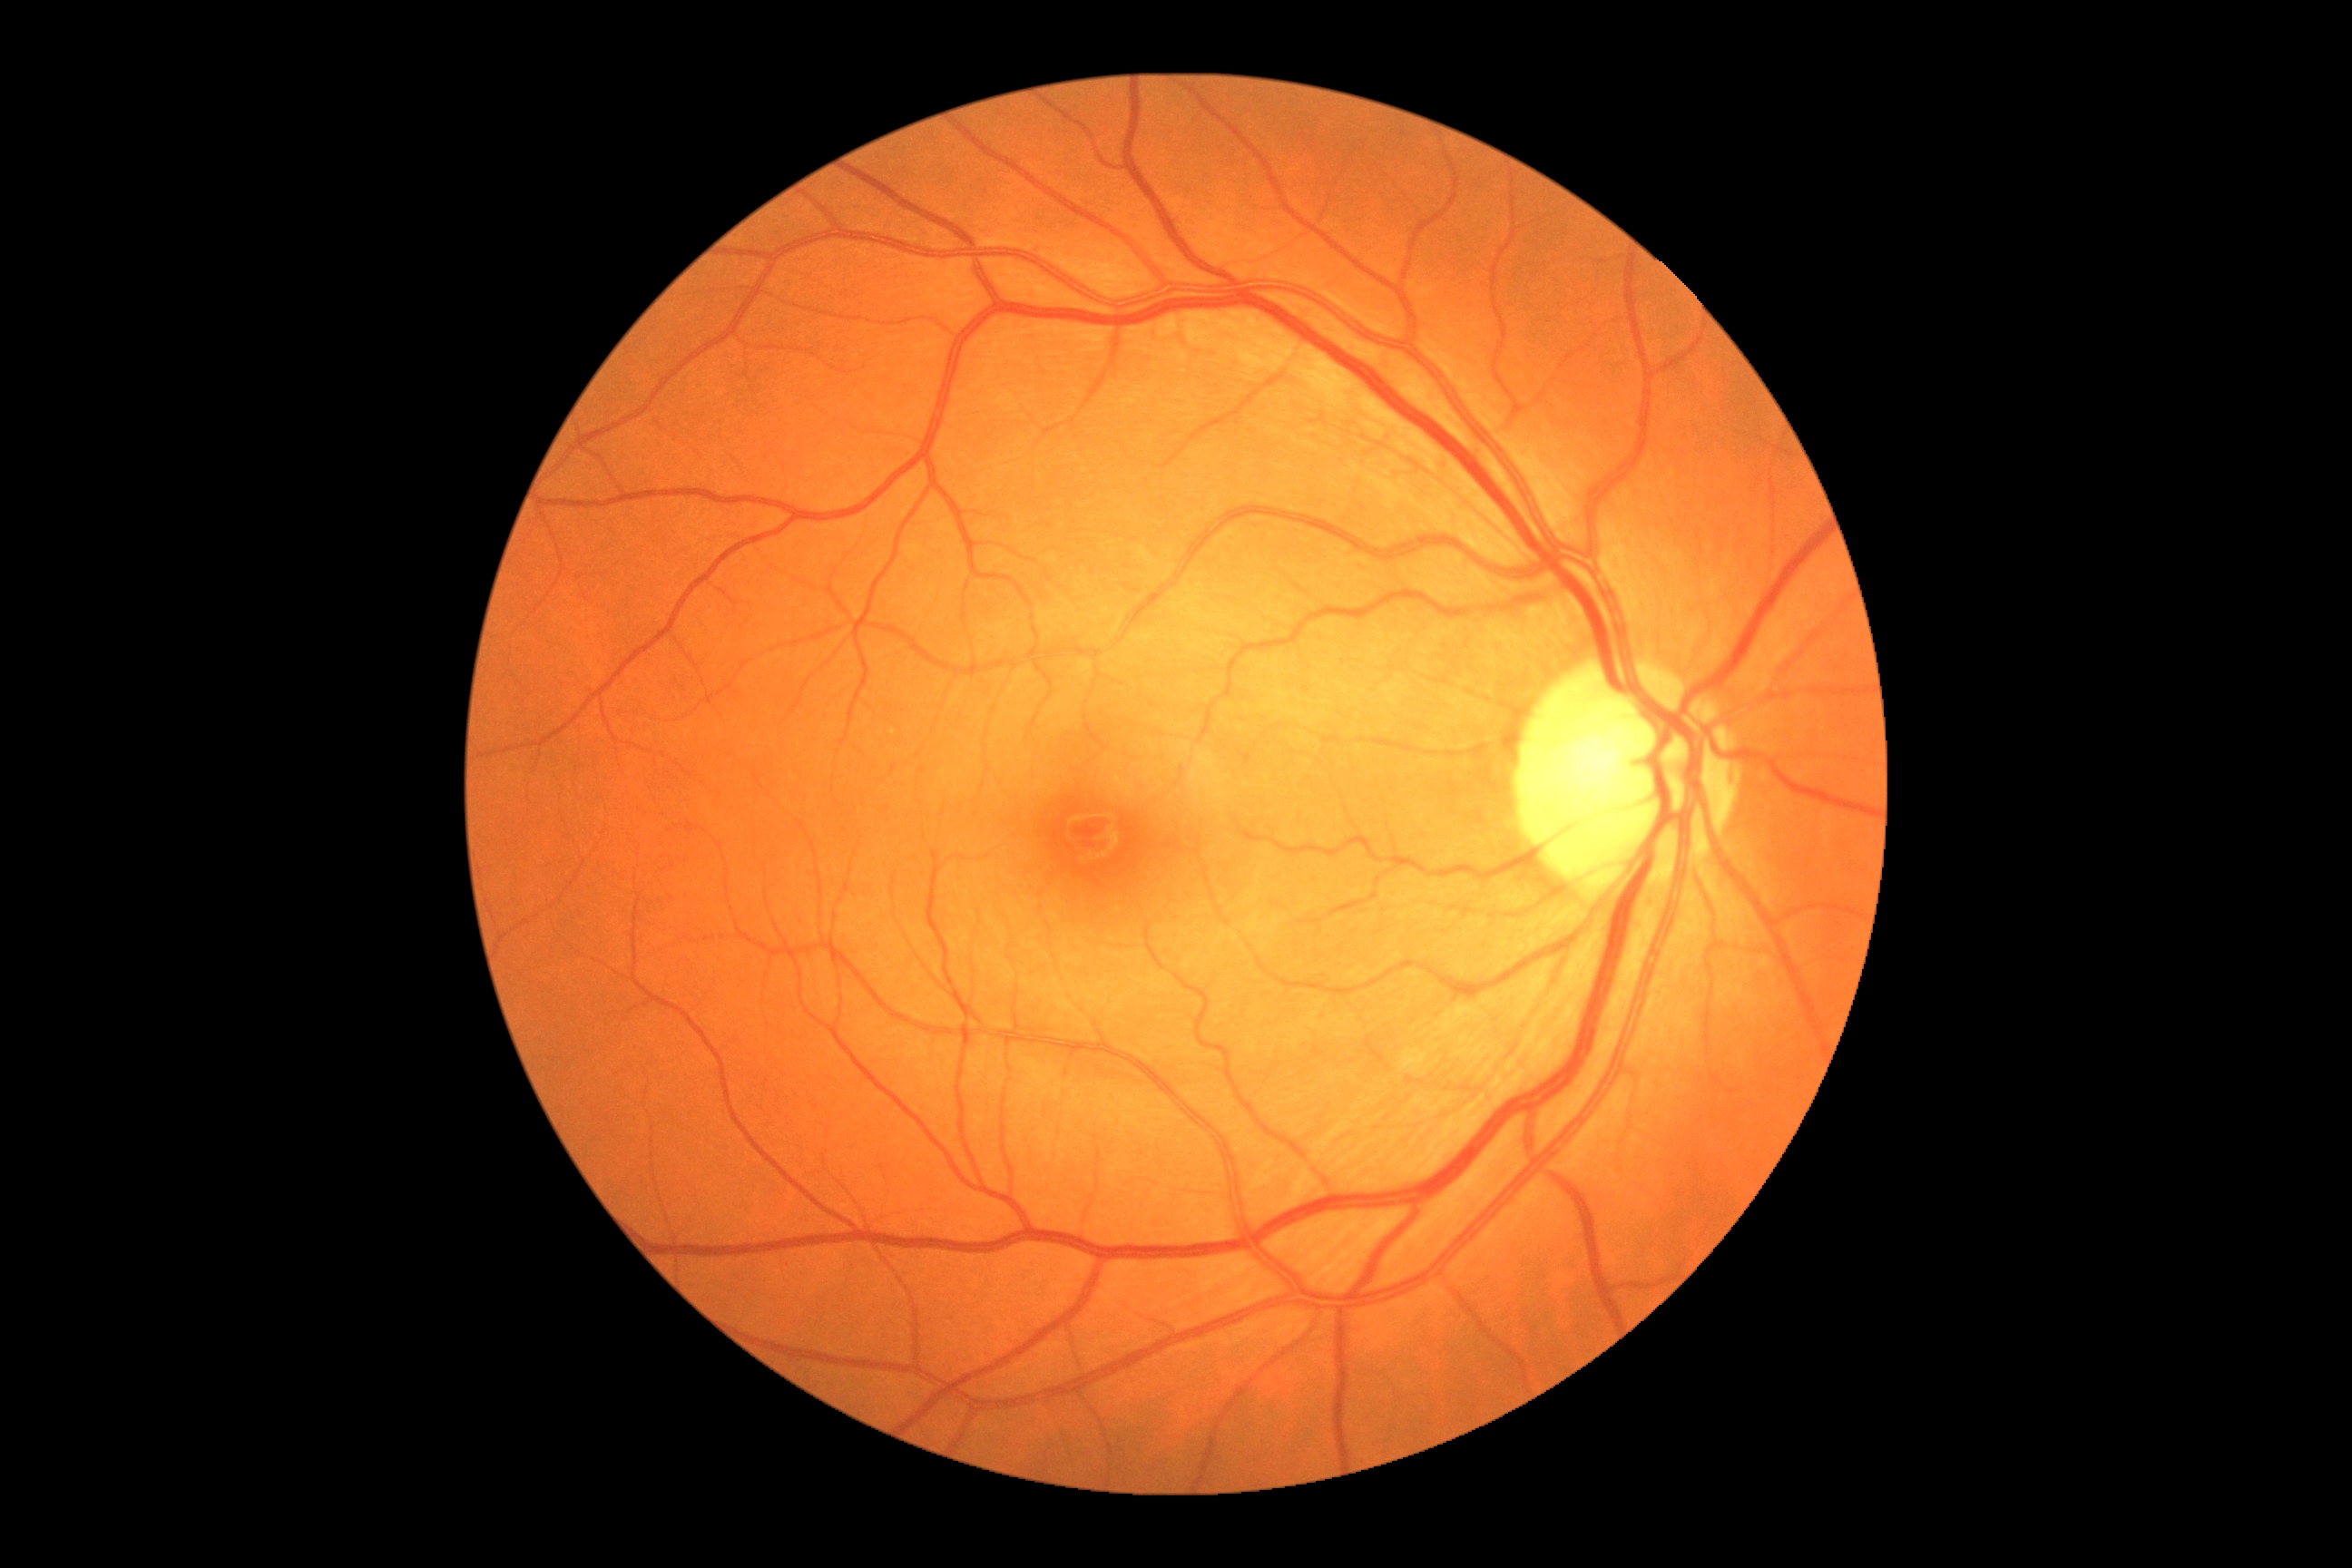

DR stage: 0.